Acquired with a NIDEK AFC-230; without pupil dilation; 45-degree field of view — 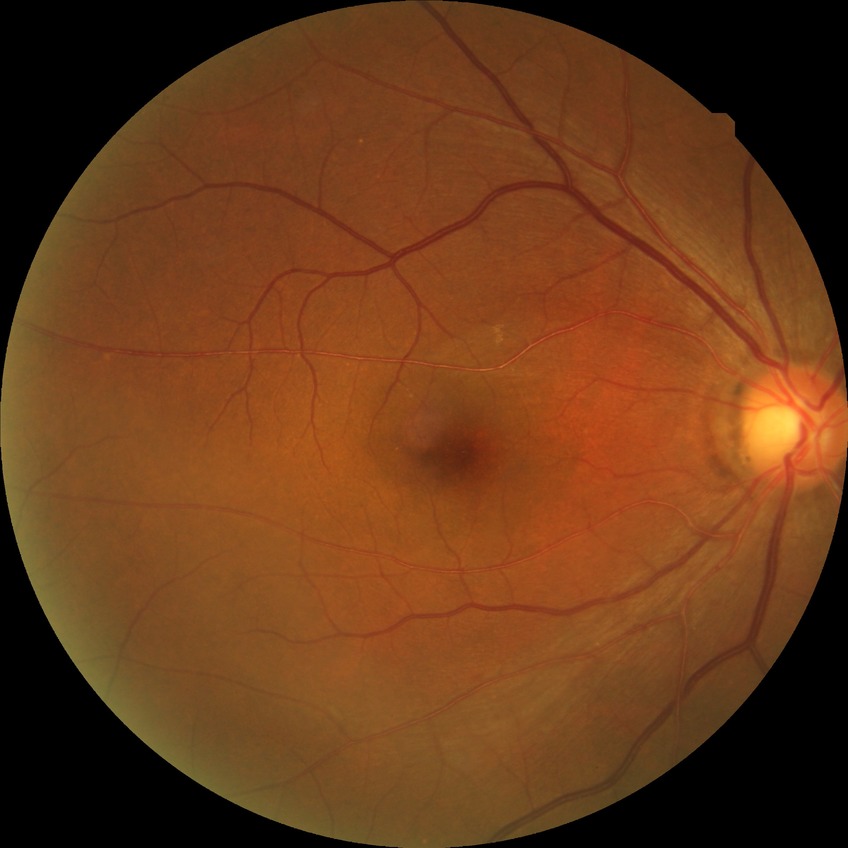

Diabetic retinopathy severity: no diabetic retinopathy.